Retinal fundus photograph: 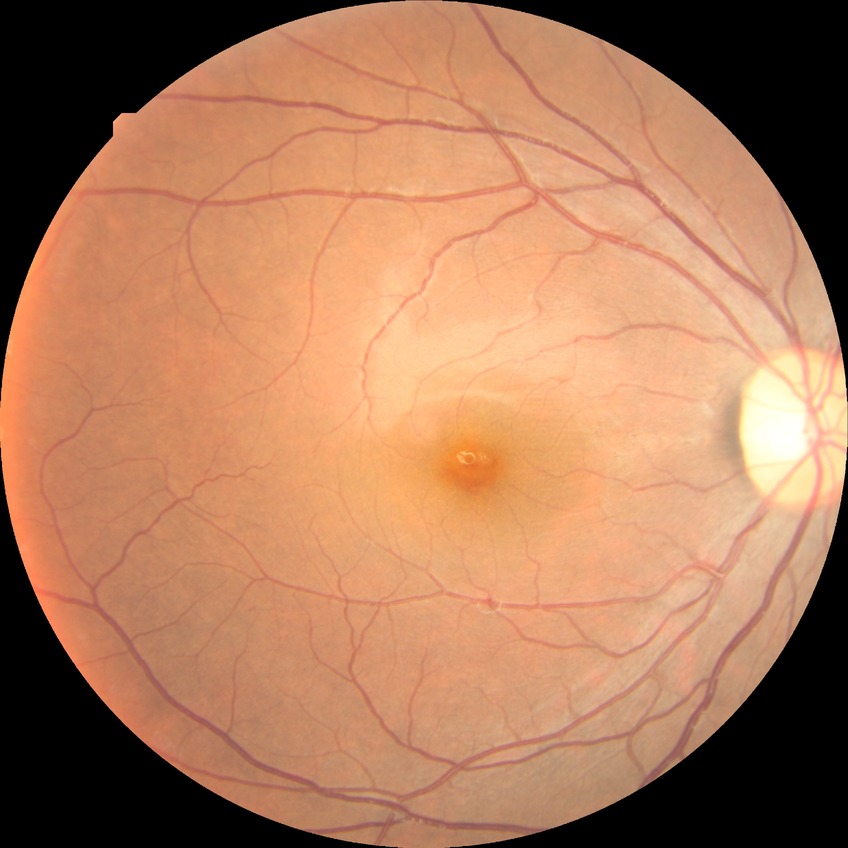 Diabetic retinopathy grade is no diabetic retinopathy.